Image size 2048x1536.
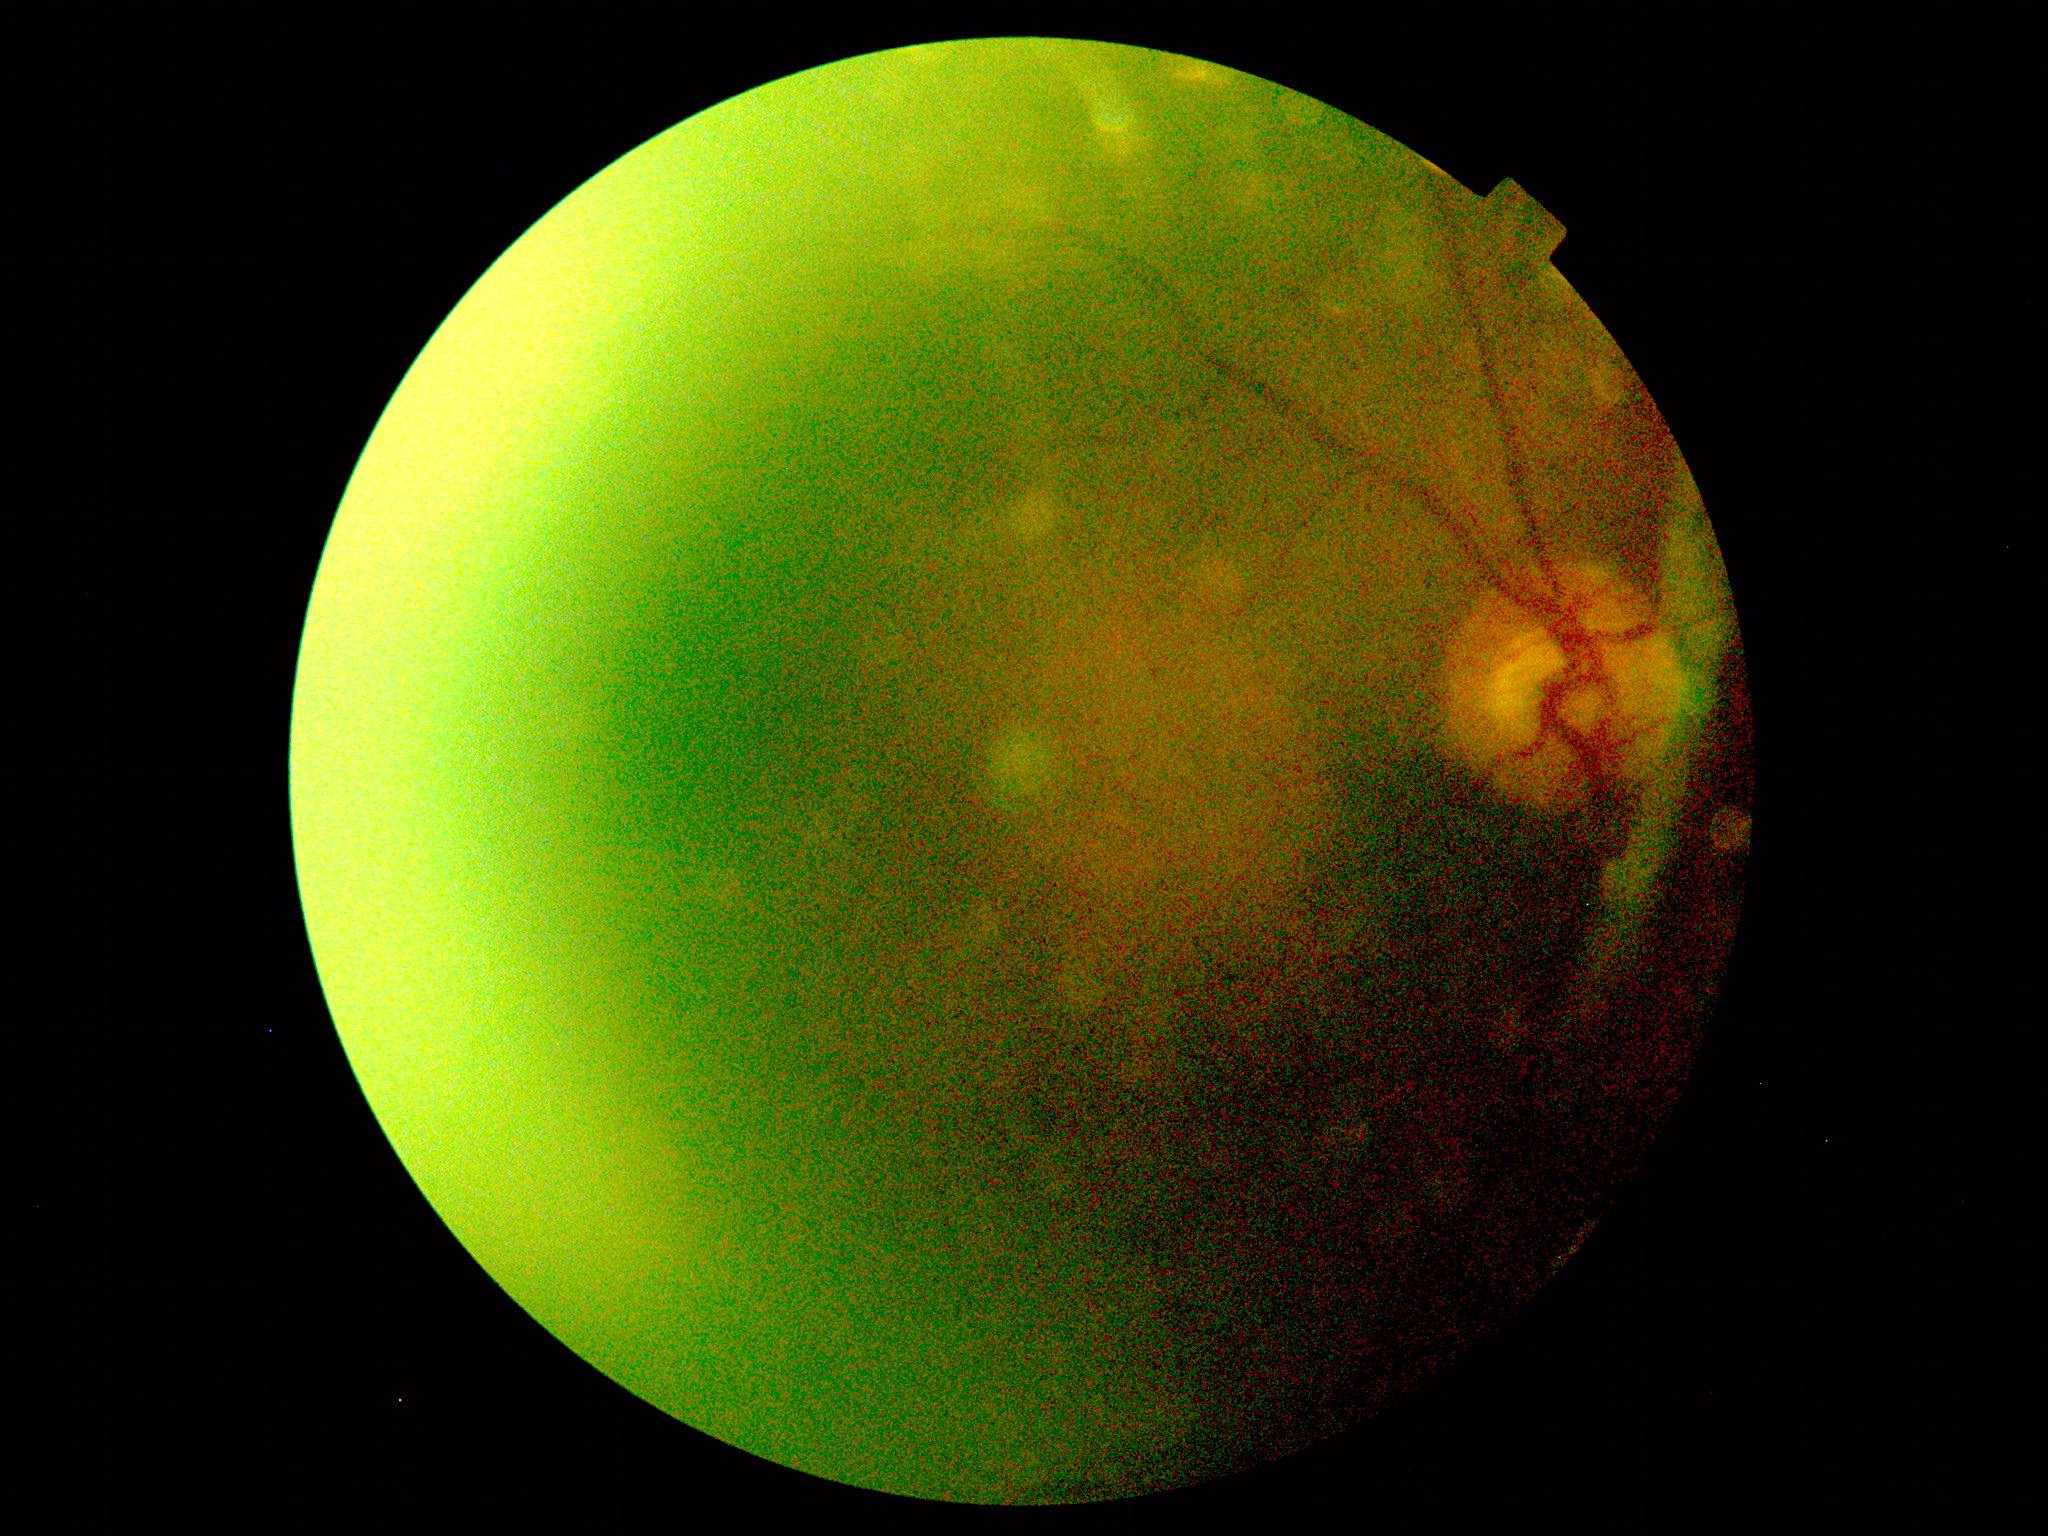

DR grade: ungradable due to poor image quality.